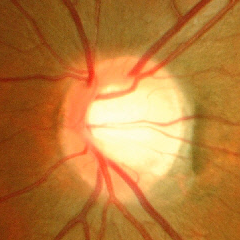
No glaucomatous findings.